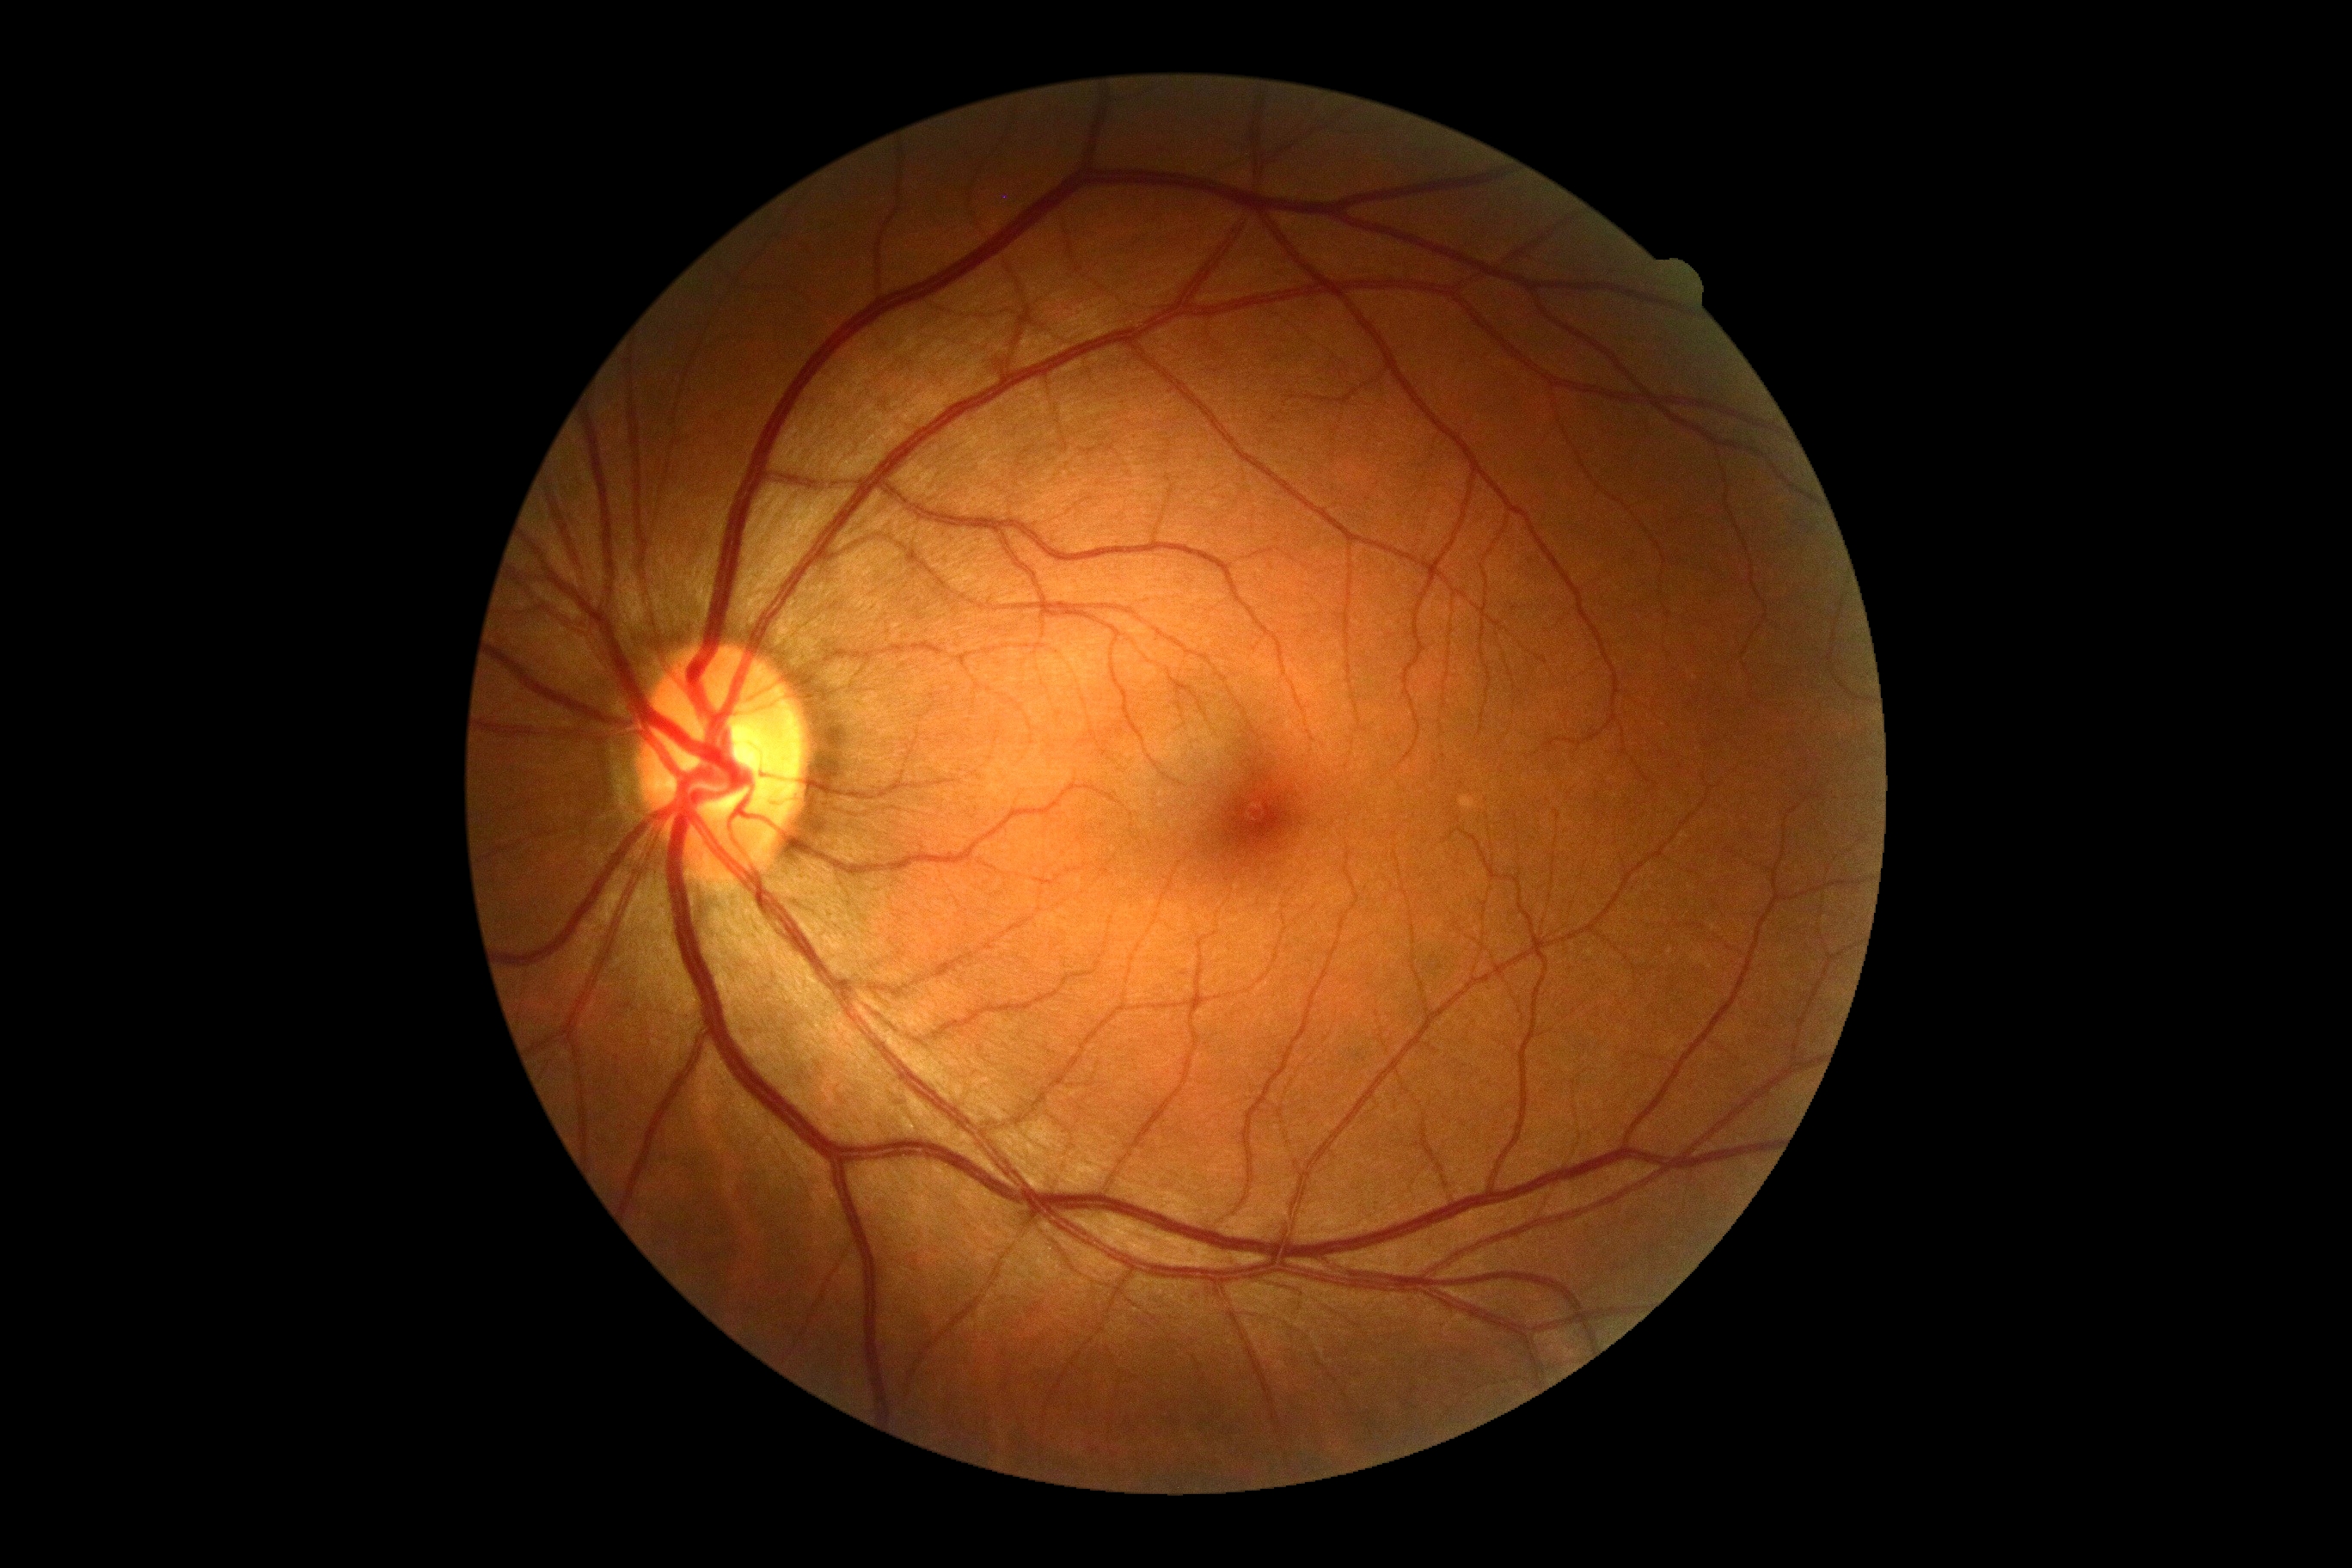
No signs of diabetic retinopathy.
DR severity: grade 0 (no apparent retinopathy).